Color fundus image: 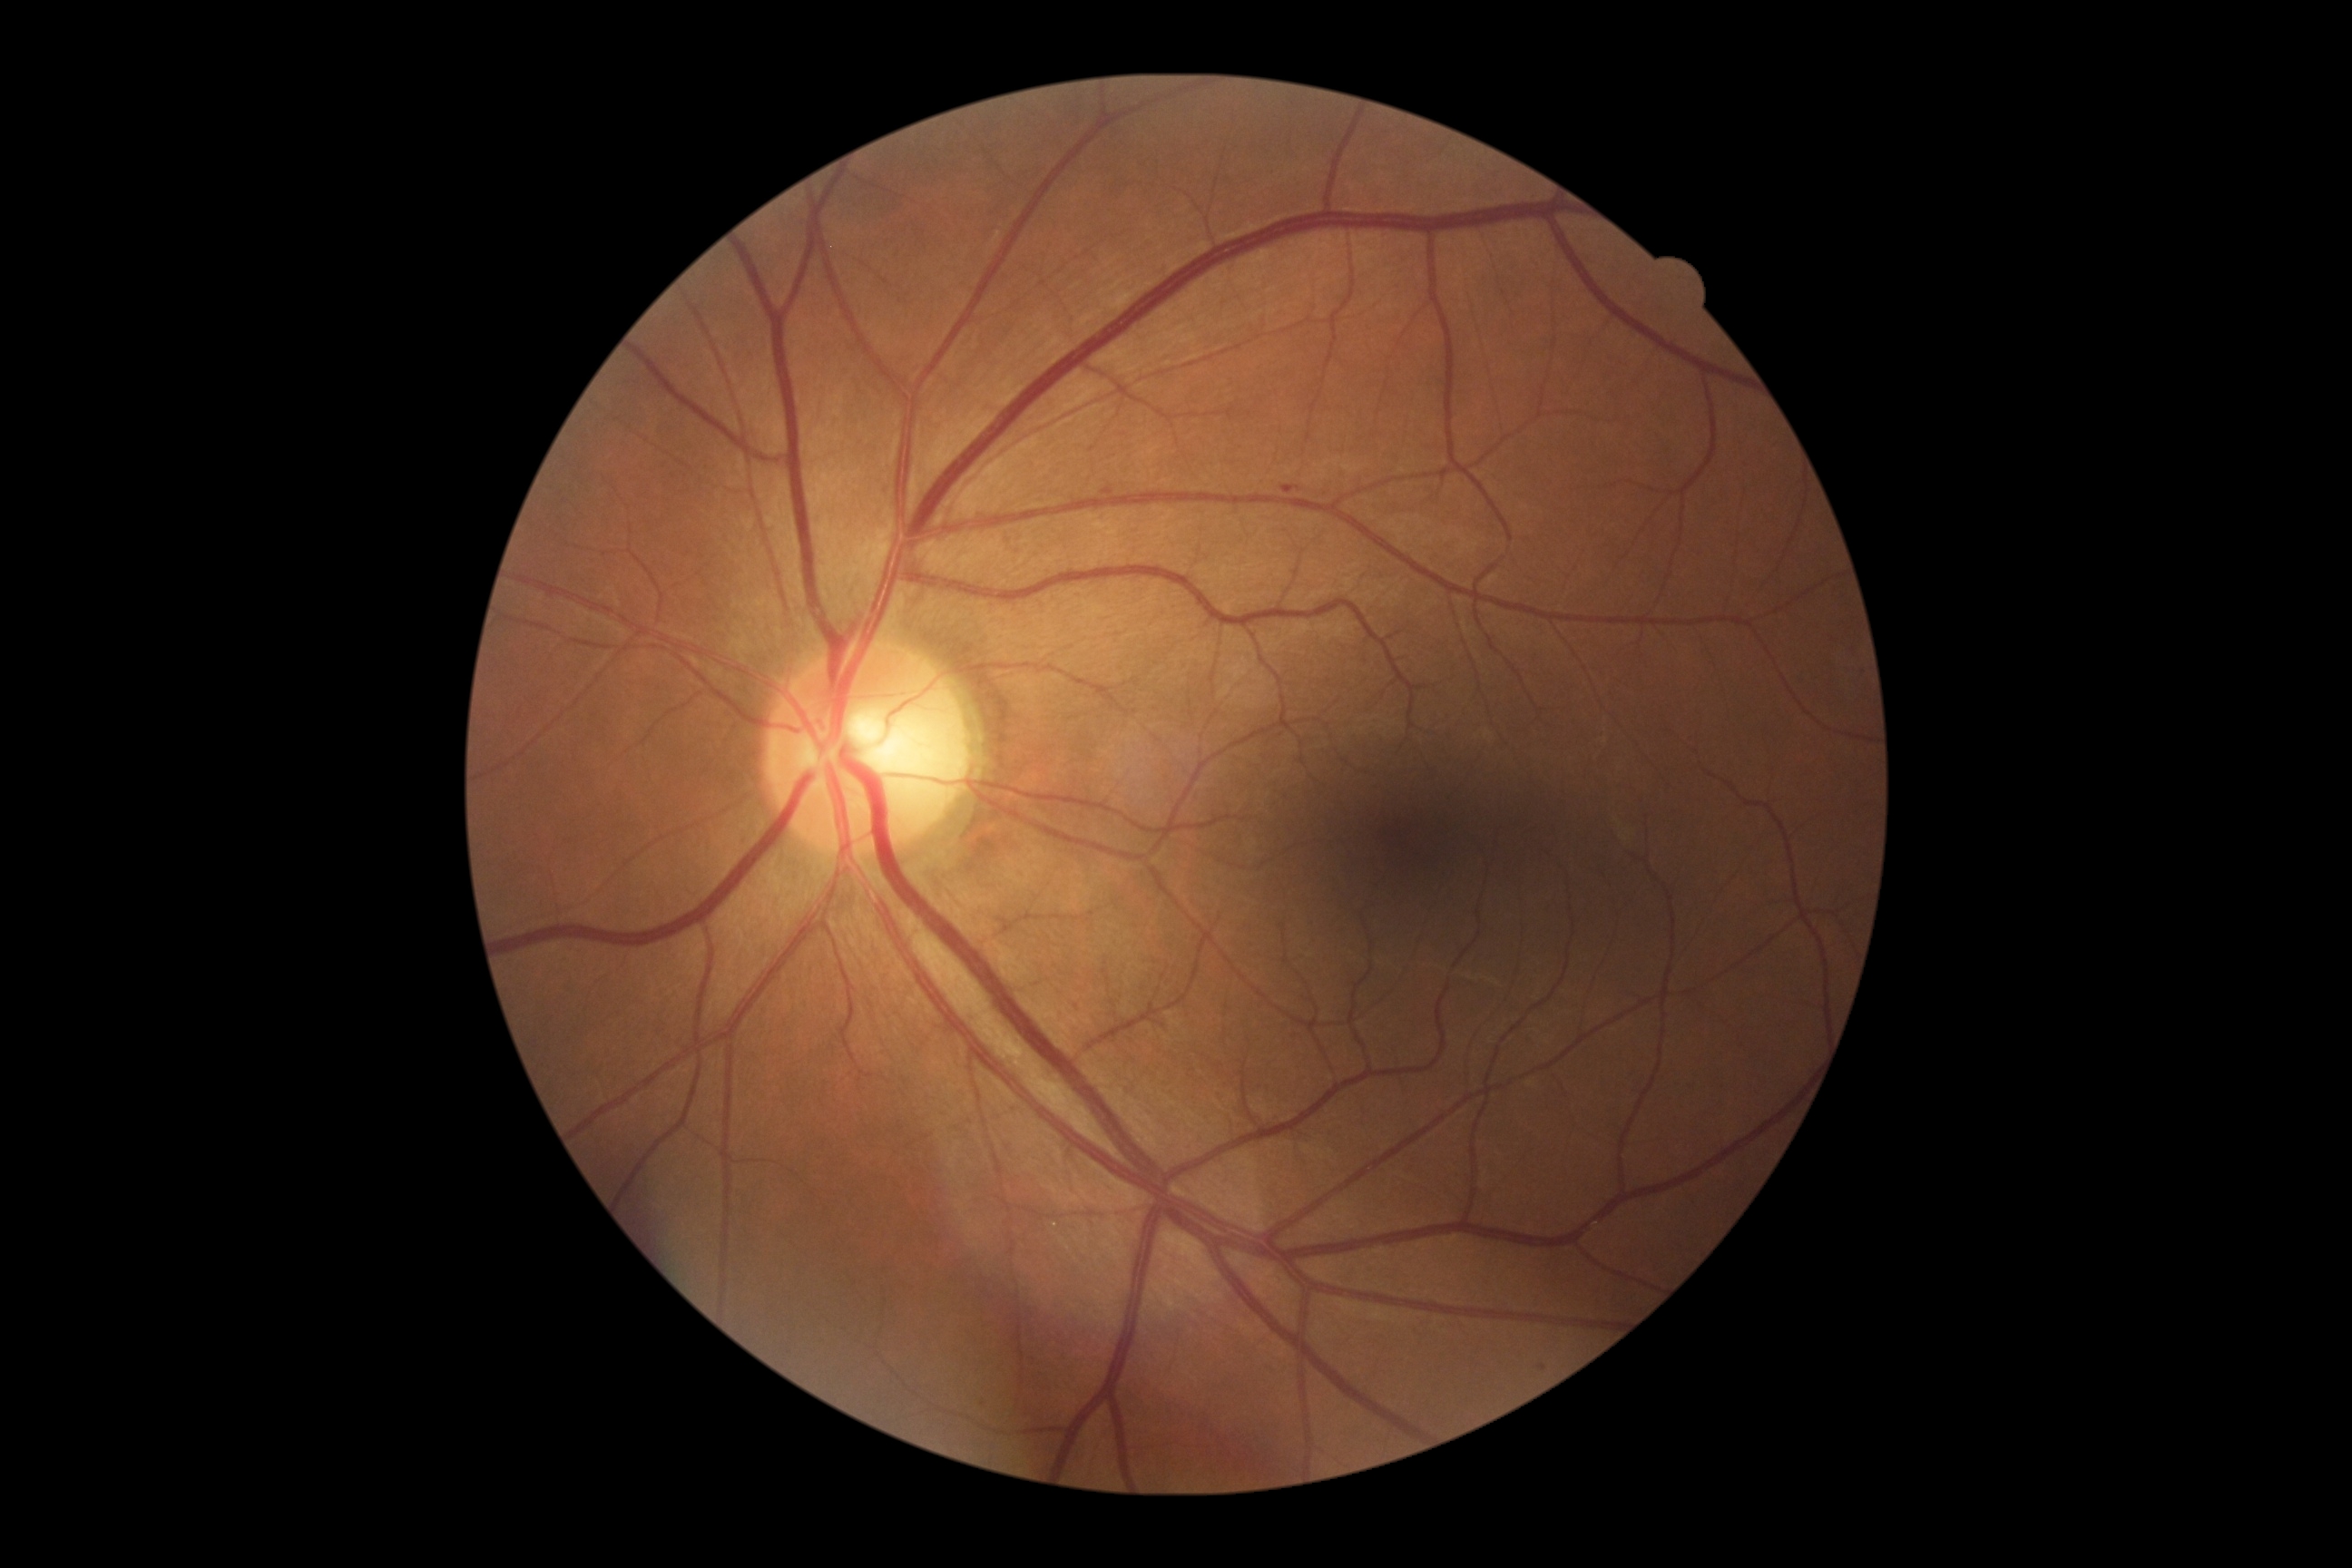 <lesions>
  <dr_grade>1</dr_grade>
  <ma>1101,485,1112,491 | 1282,485,1302,495</ma>
  <ma_small_centers>[x=1543, y=1368]</ma_small_centers>
  <ex />
  <he />
  <se />
</lesions>